Ultra-widefield (UWF) fundus image:
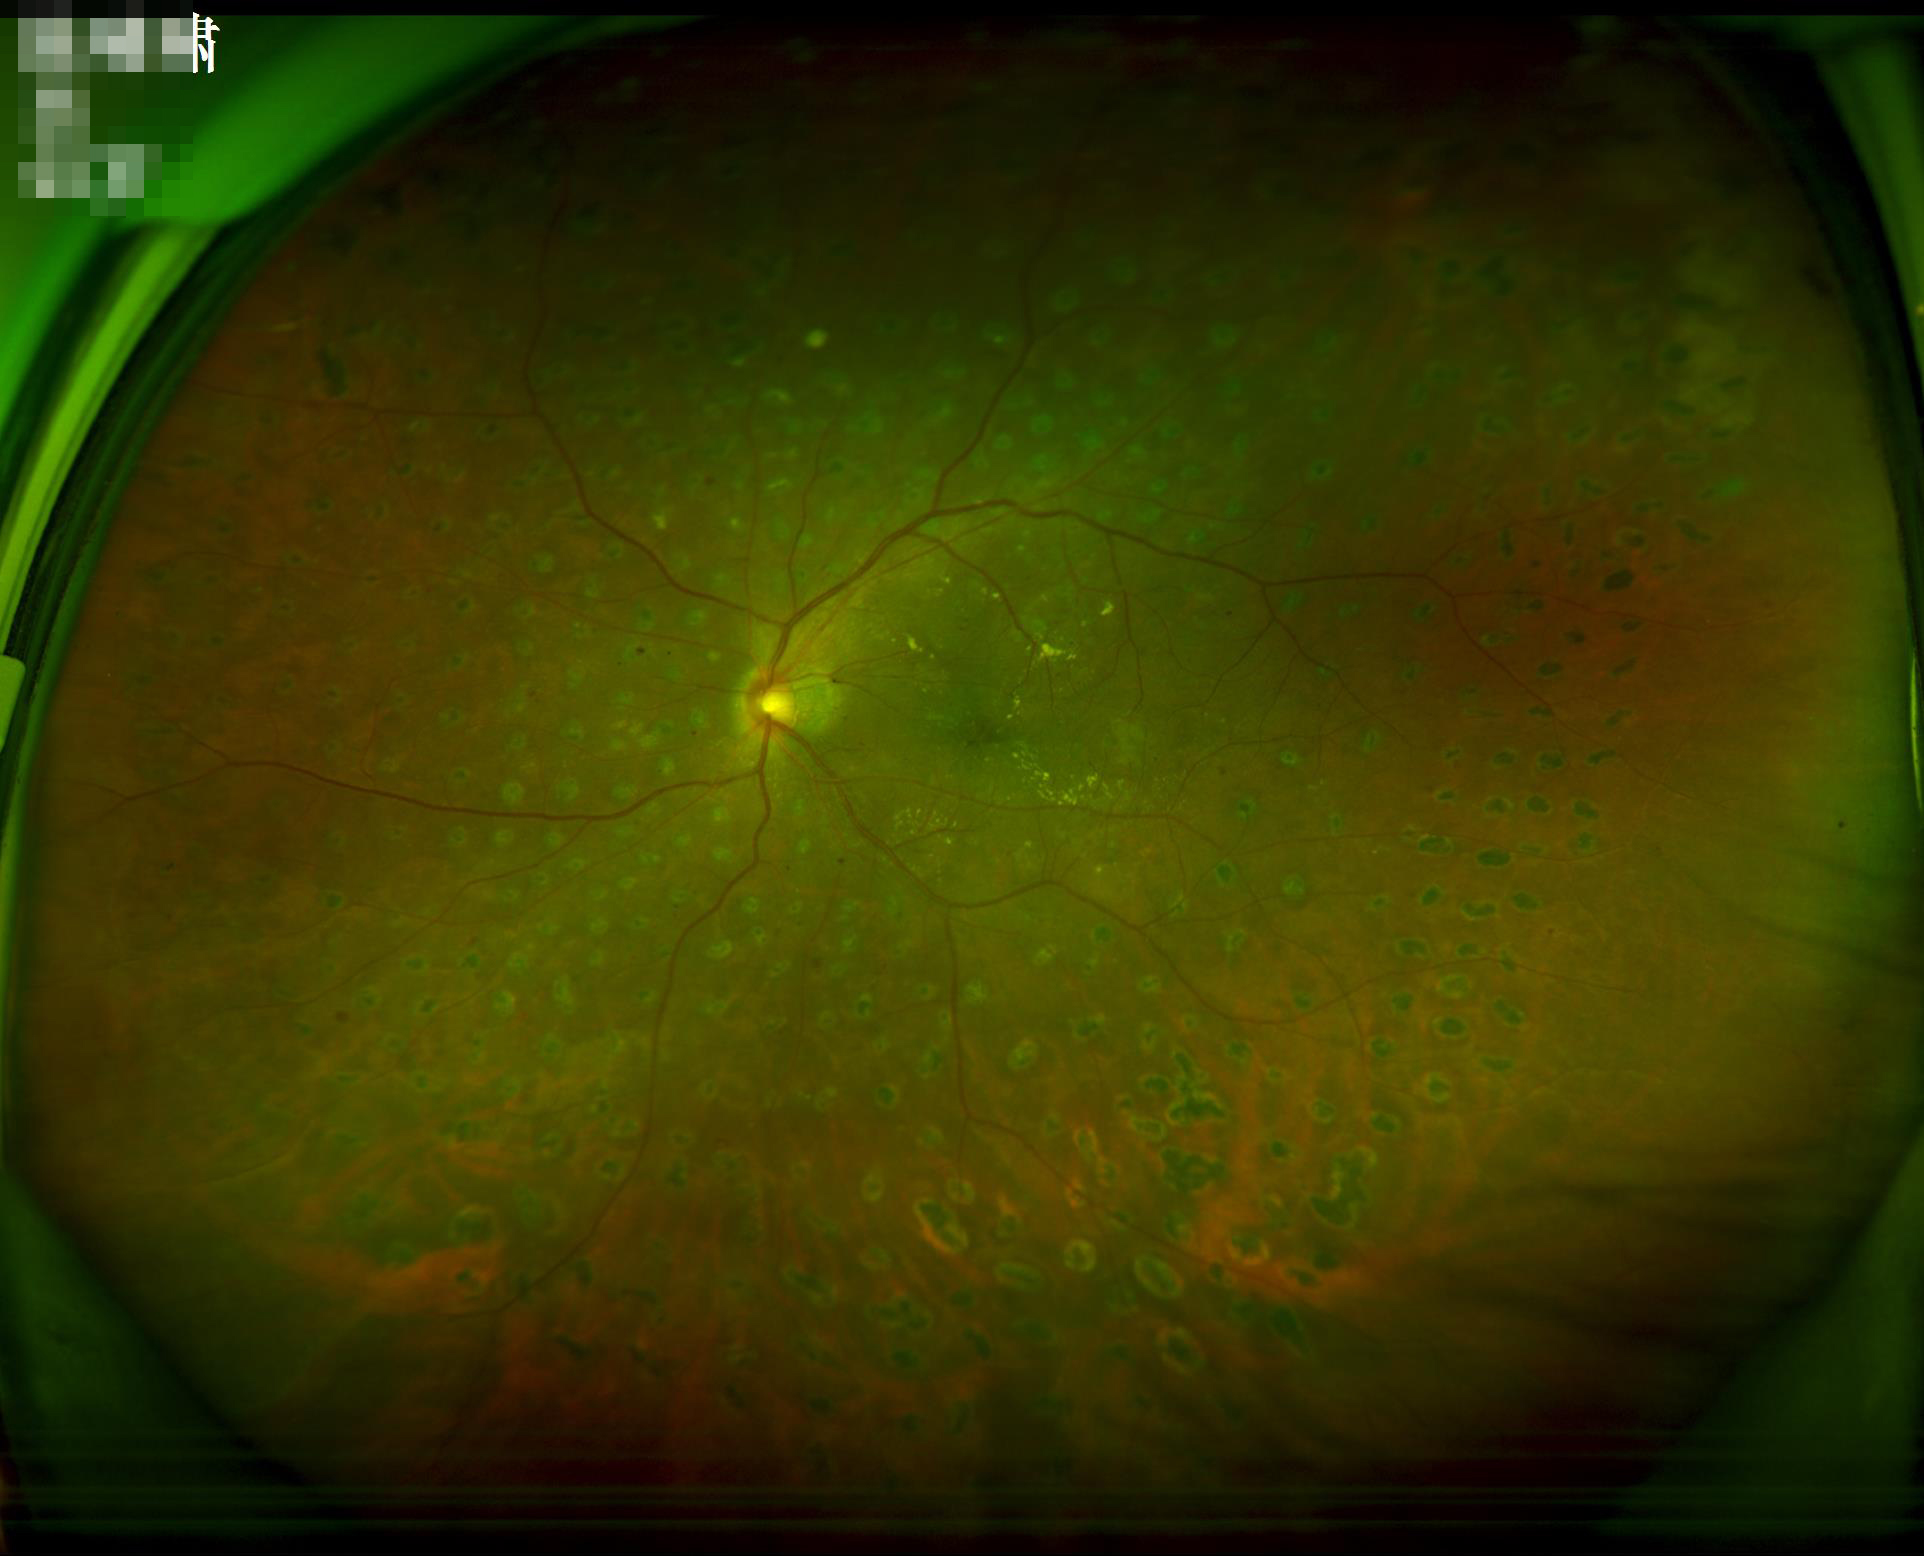 No noticeable blur. Image quality is adequate for diagnostic use. Adequate contrast for distinguishing structures.